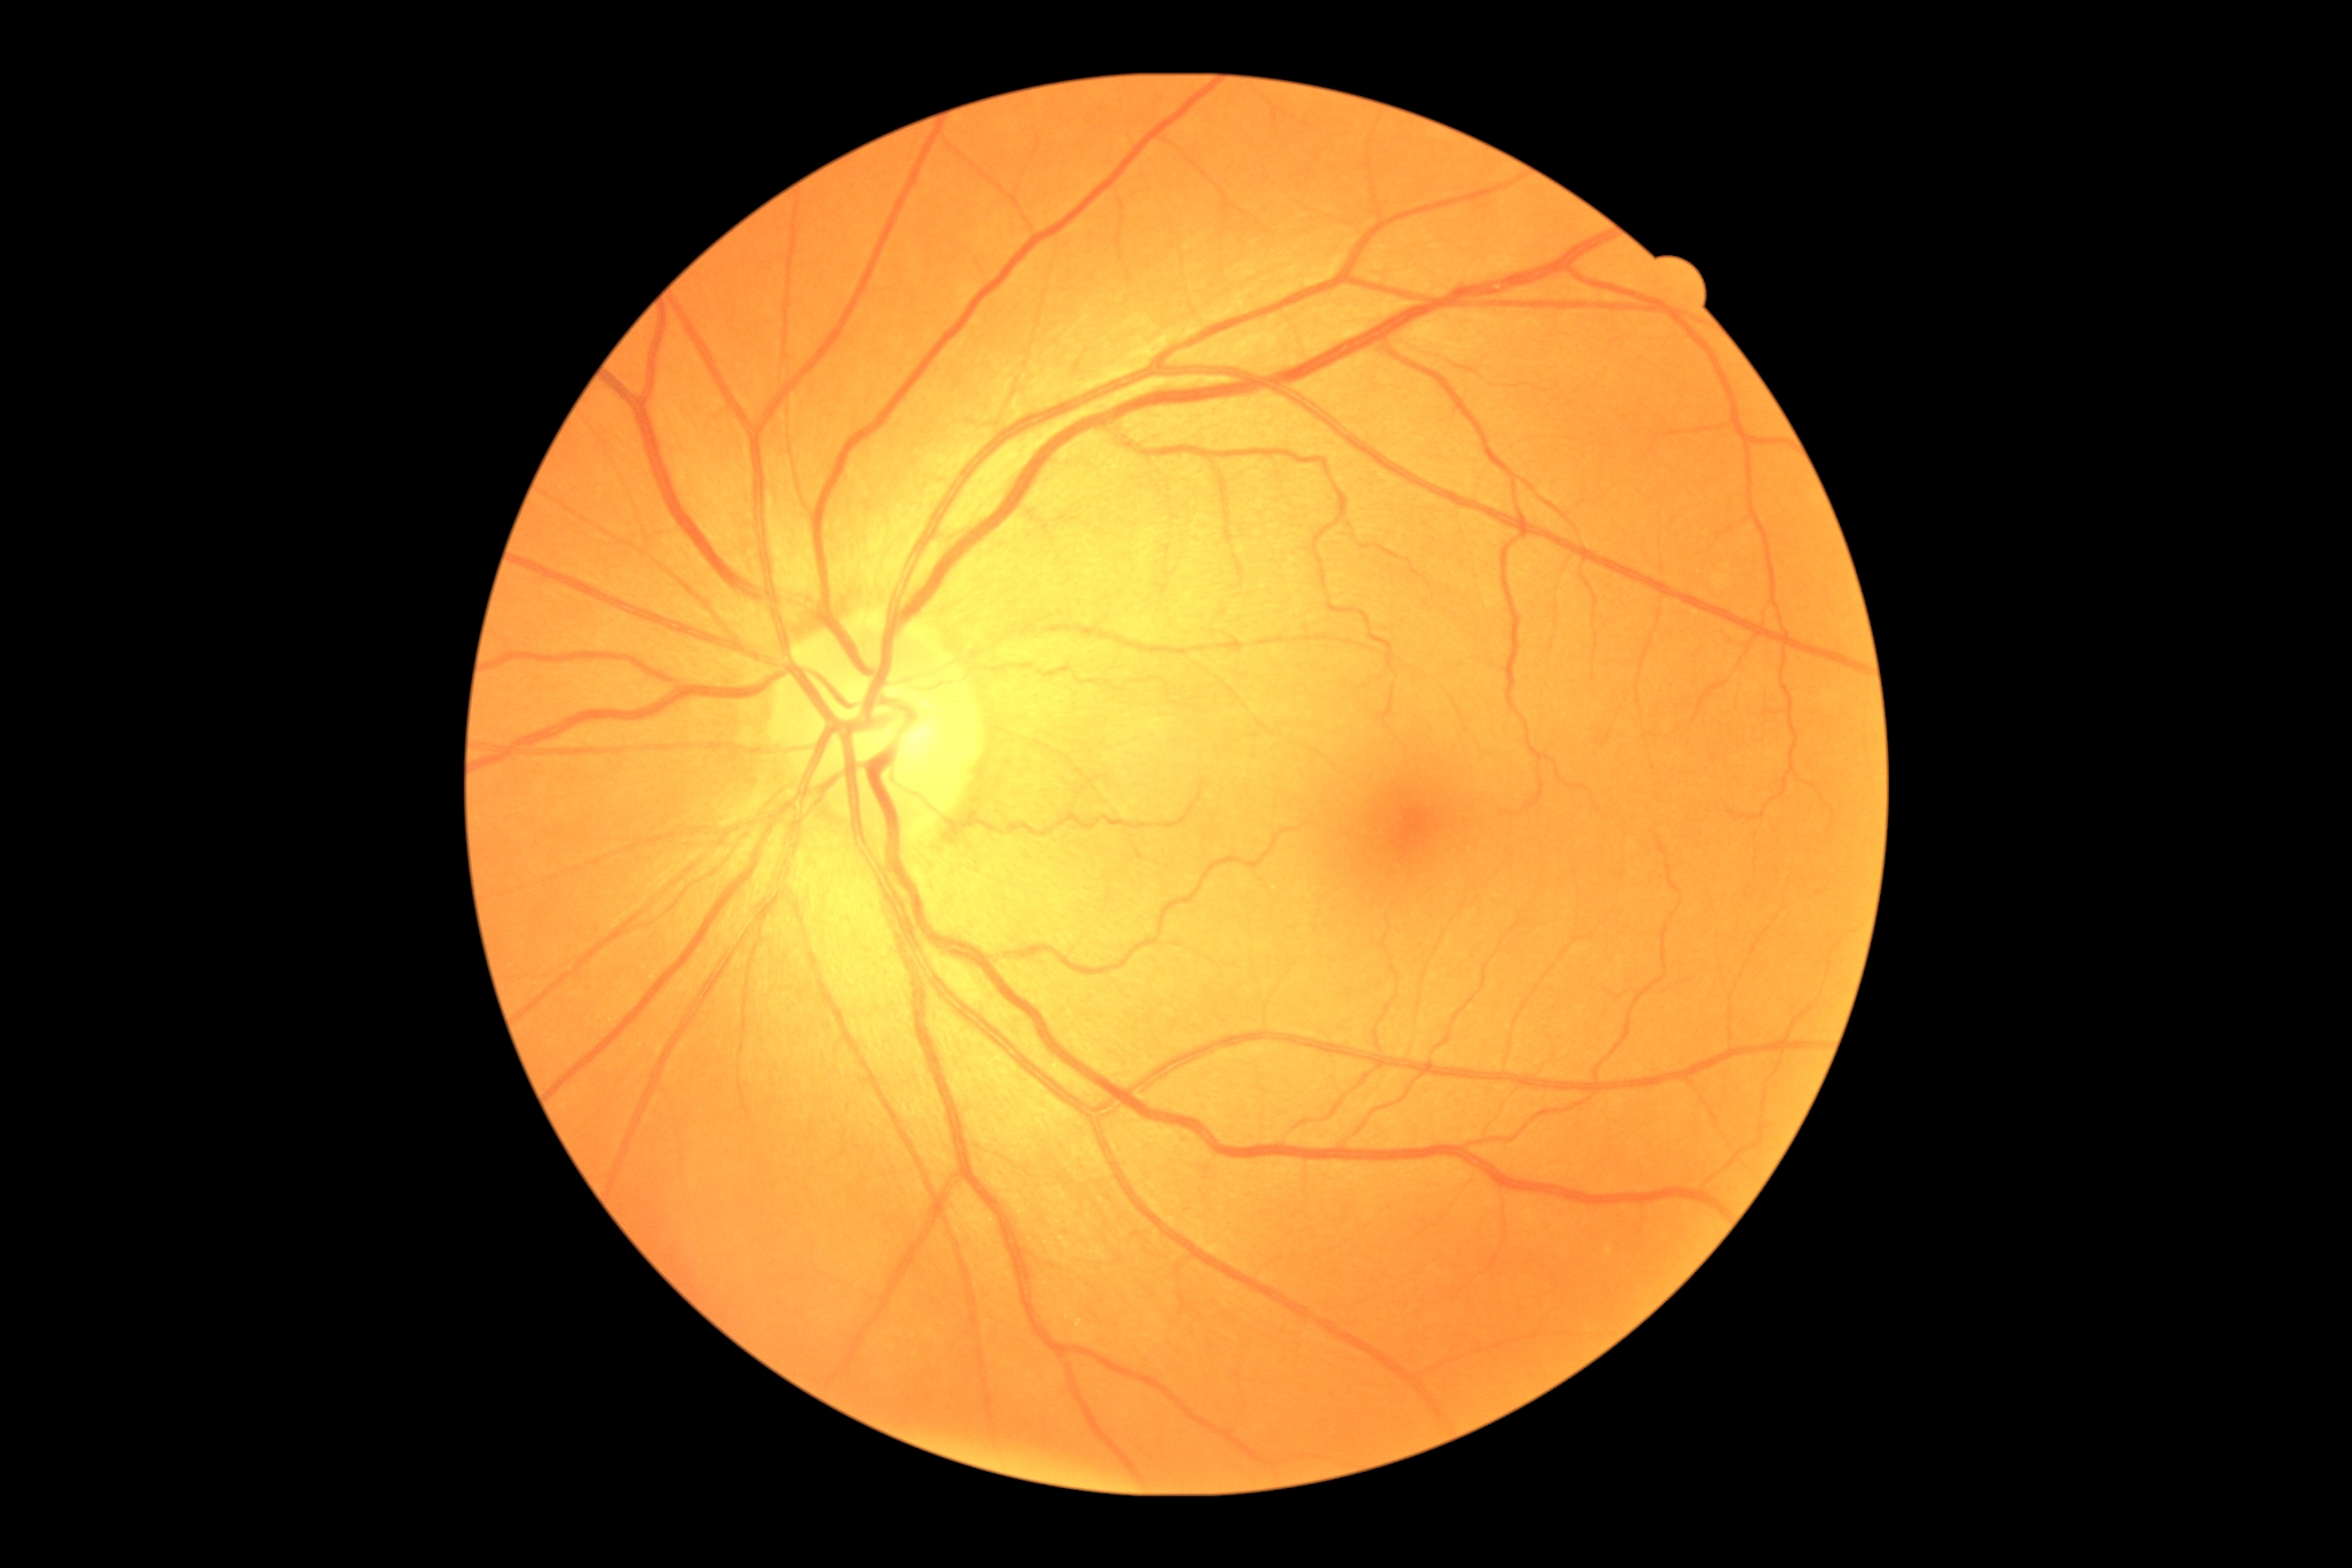

DR impression: no DR findings; DR: grade 0 (no apparent retinopathy).